Wide-field fundus photograph from neonatal ROP screening:
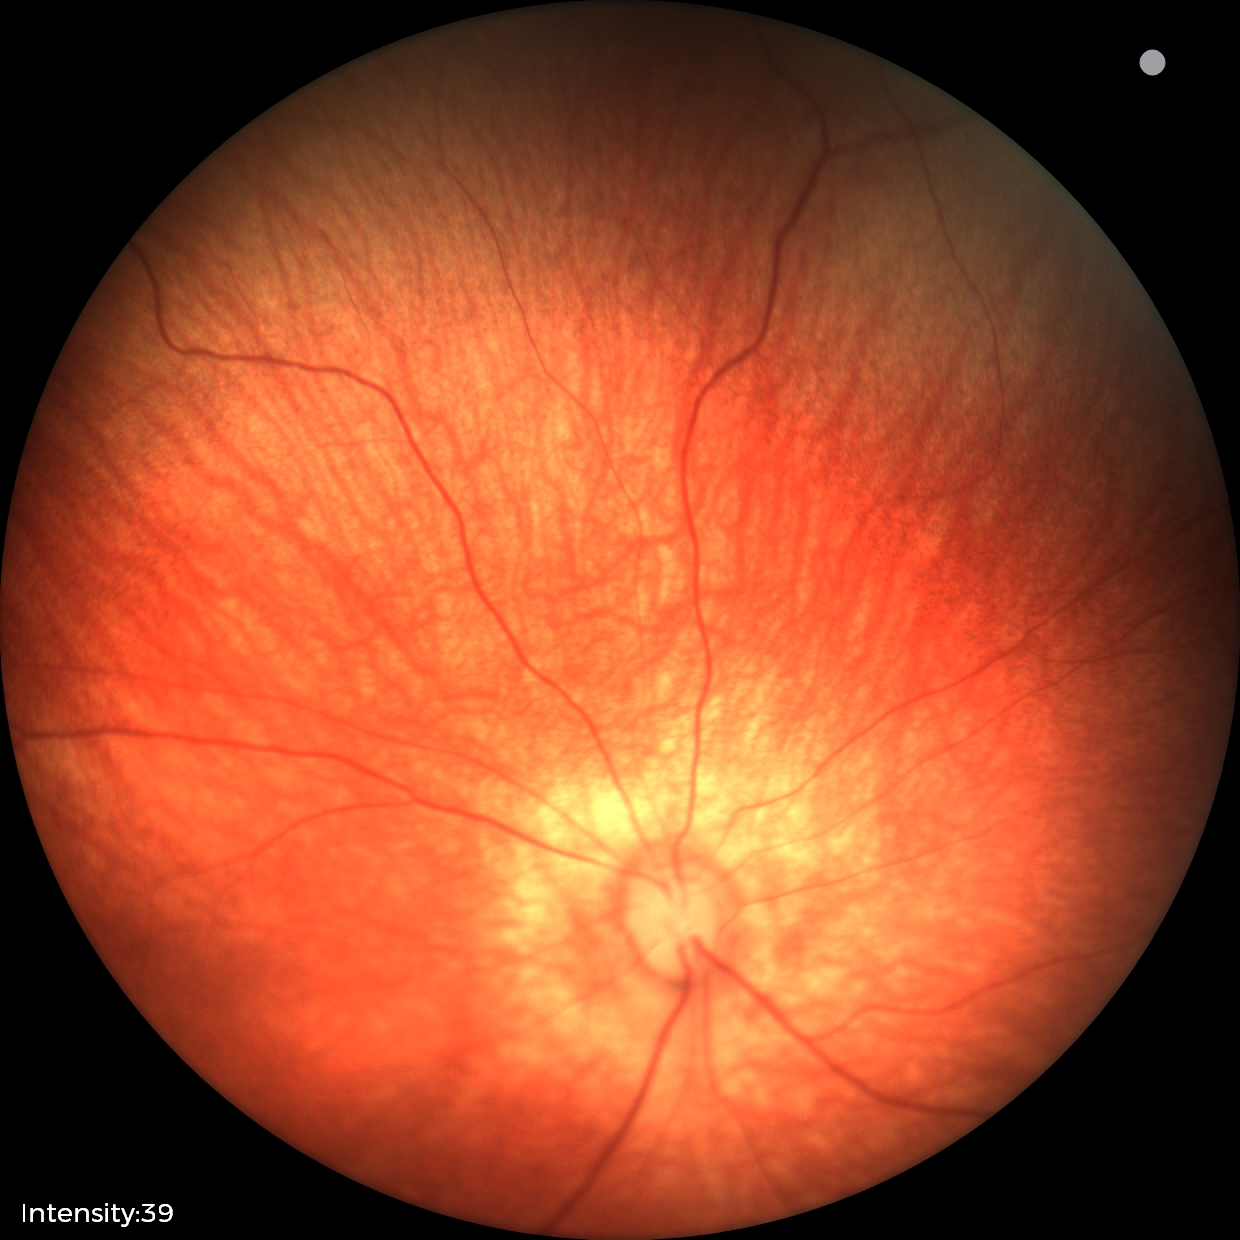

No retinal pathology identified on screening.